50° field of view — 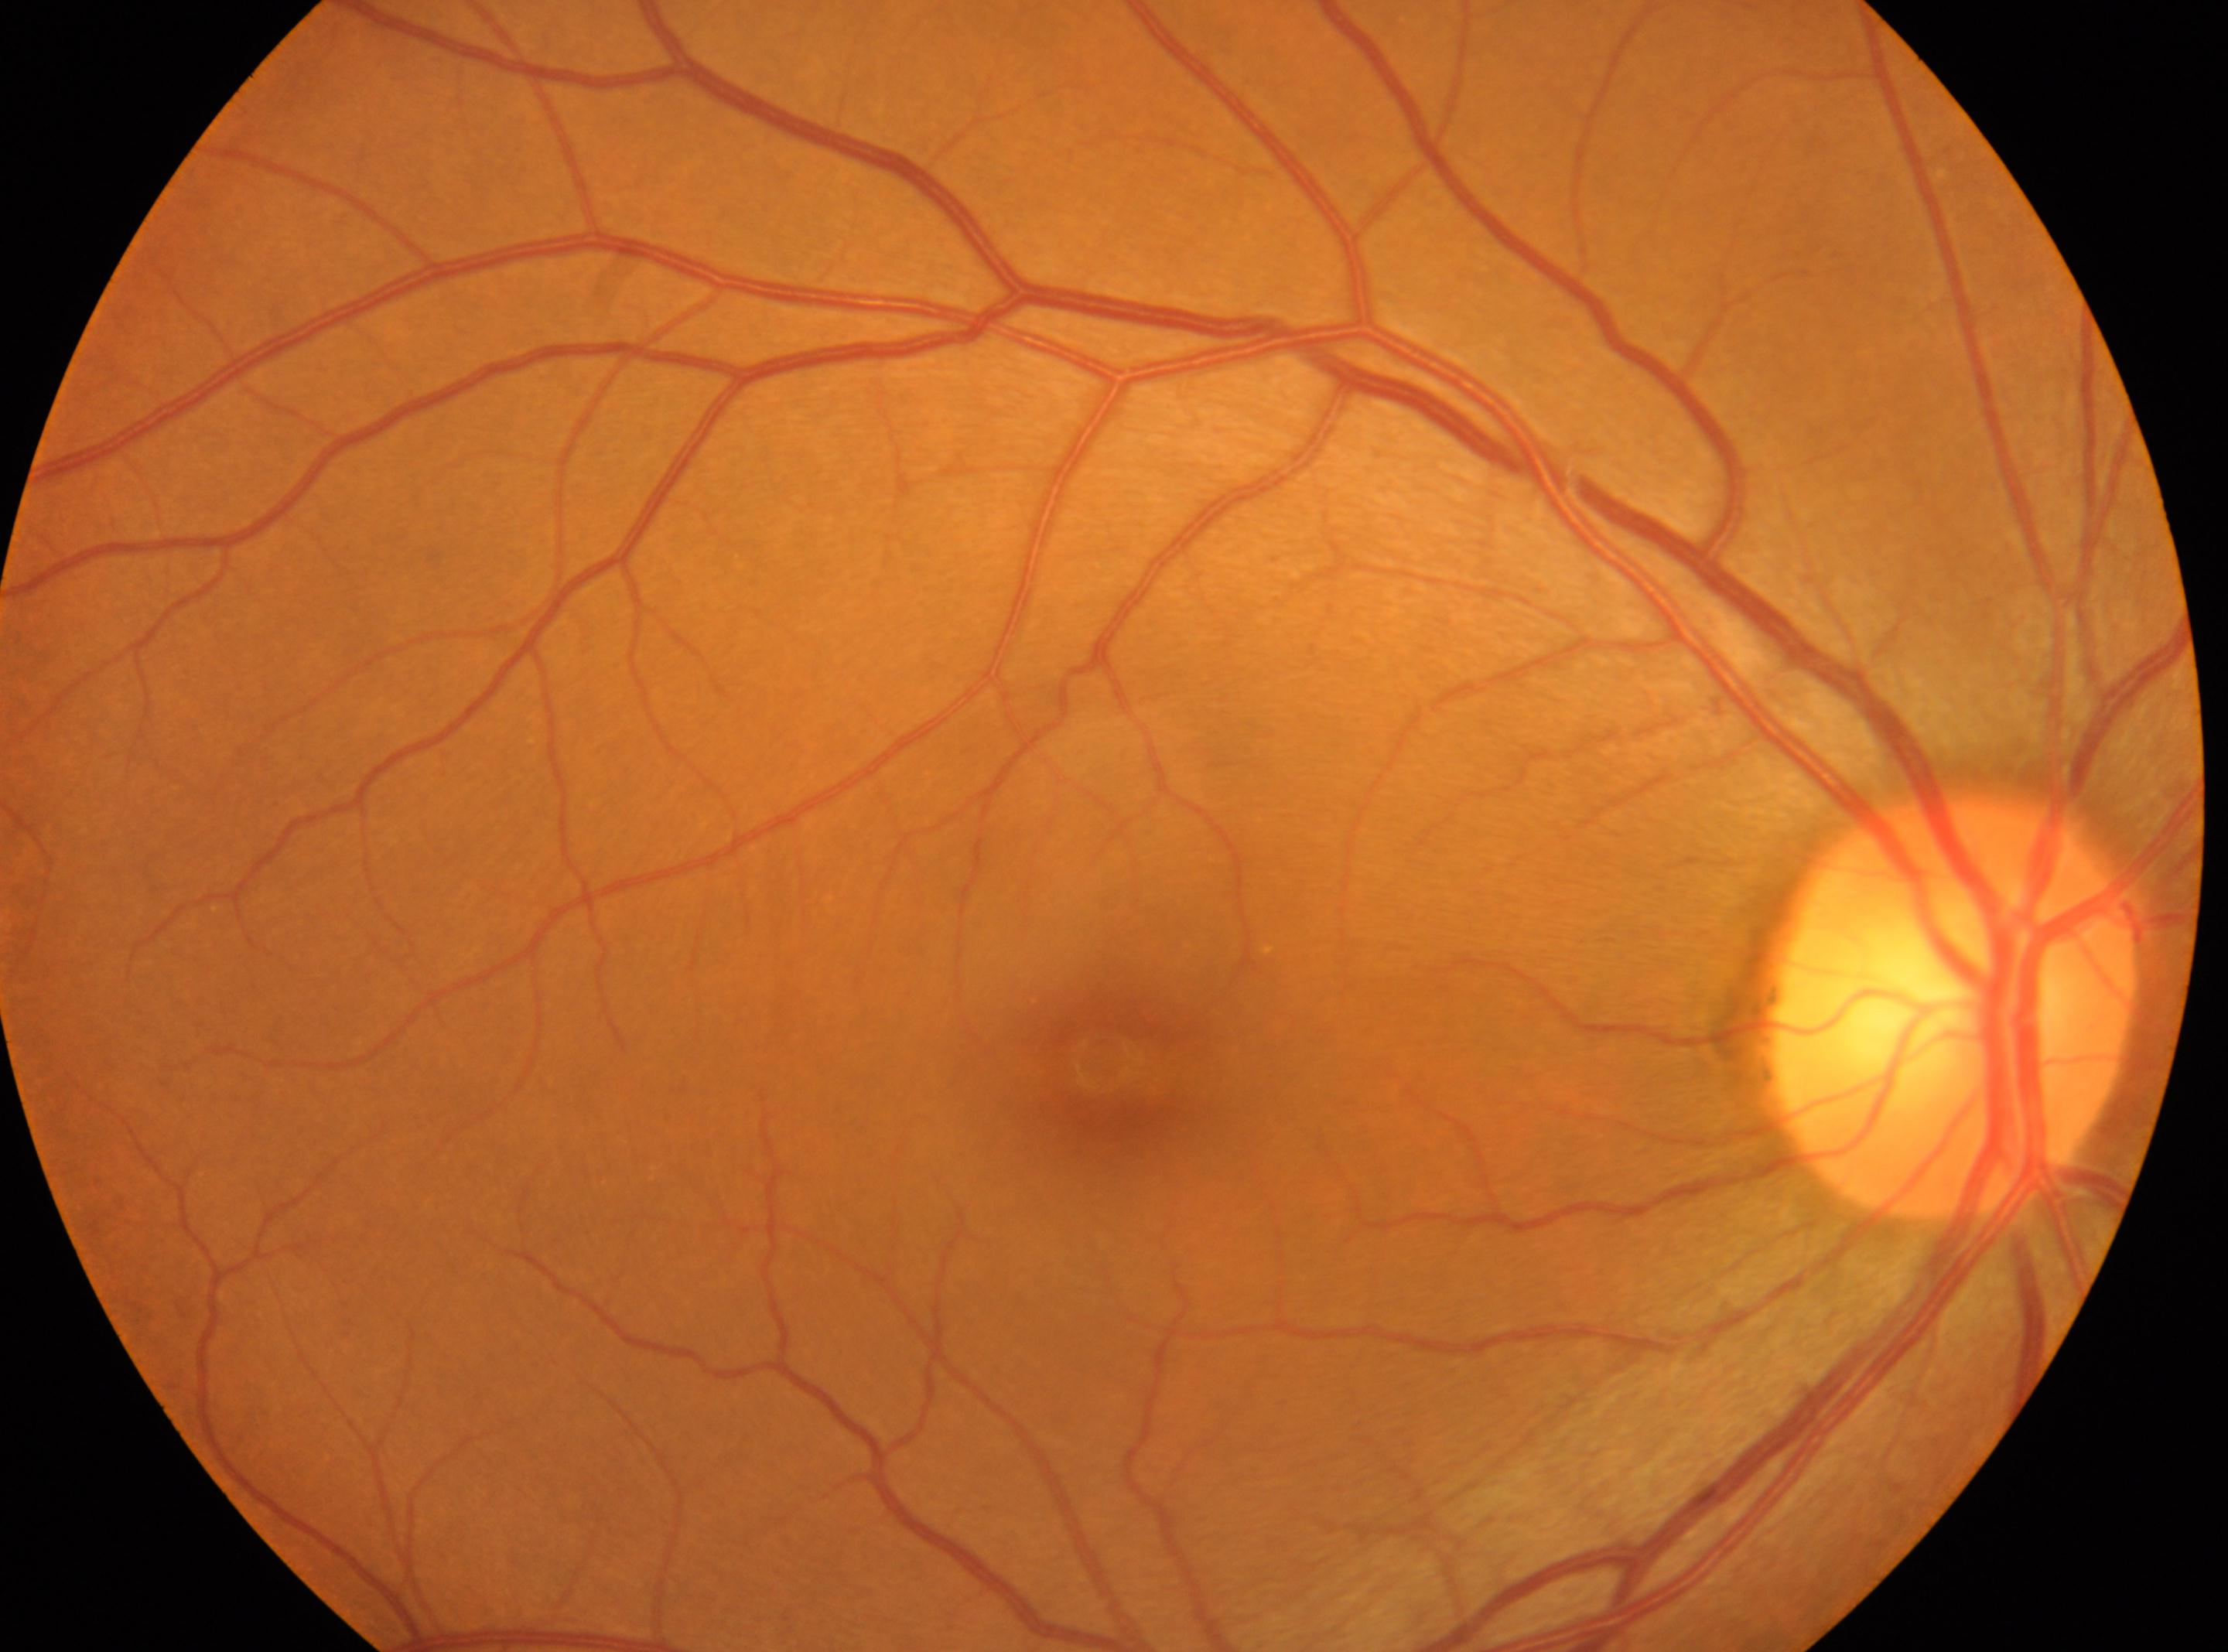
Macula center located at (x=1108, y=1063). Eye: right eye. Diabetic retinopathy is 0. The optic disc is at (x=1954, y=1009).